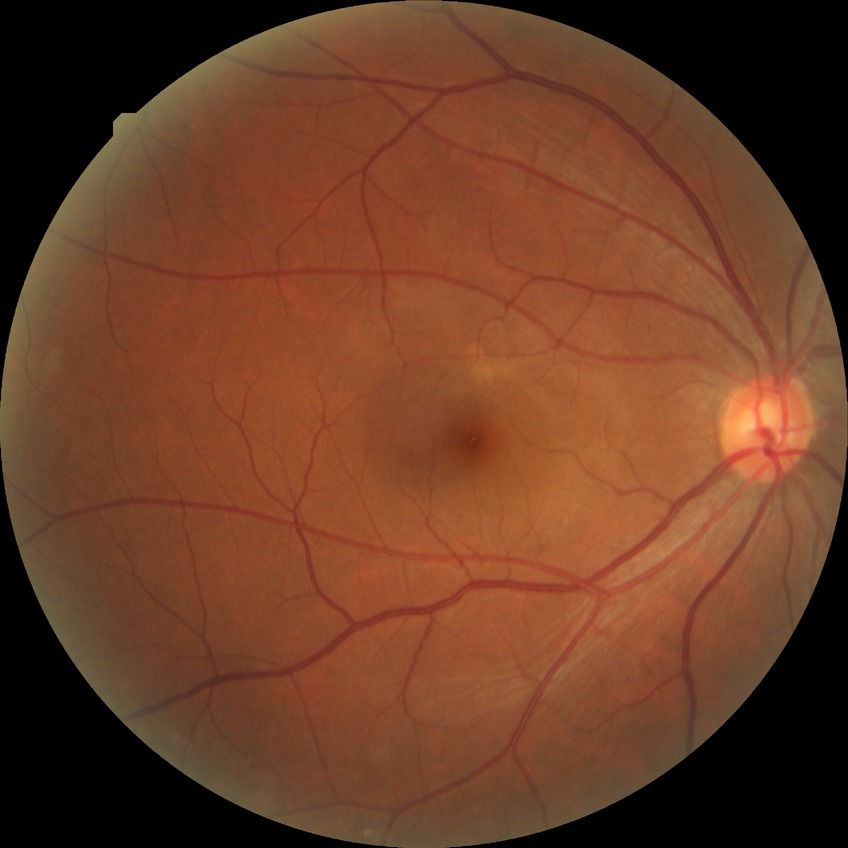

Diabetic retinopathy severity: no diabetic retinopathy.